Color fundus image
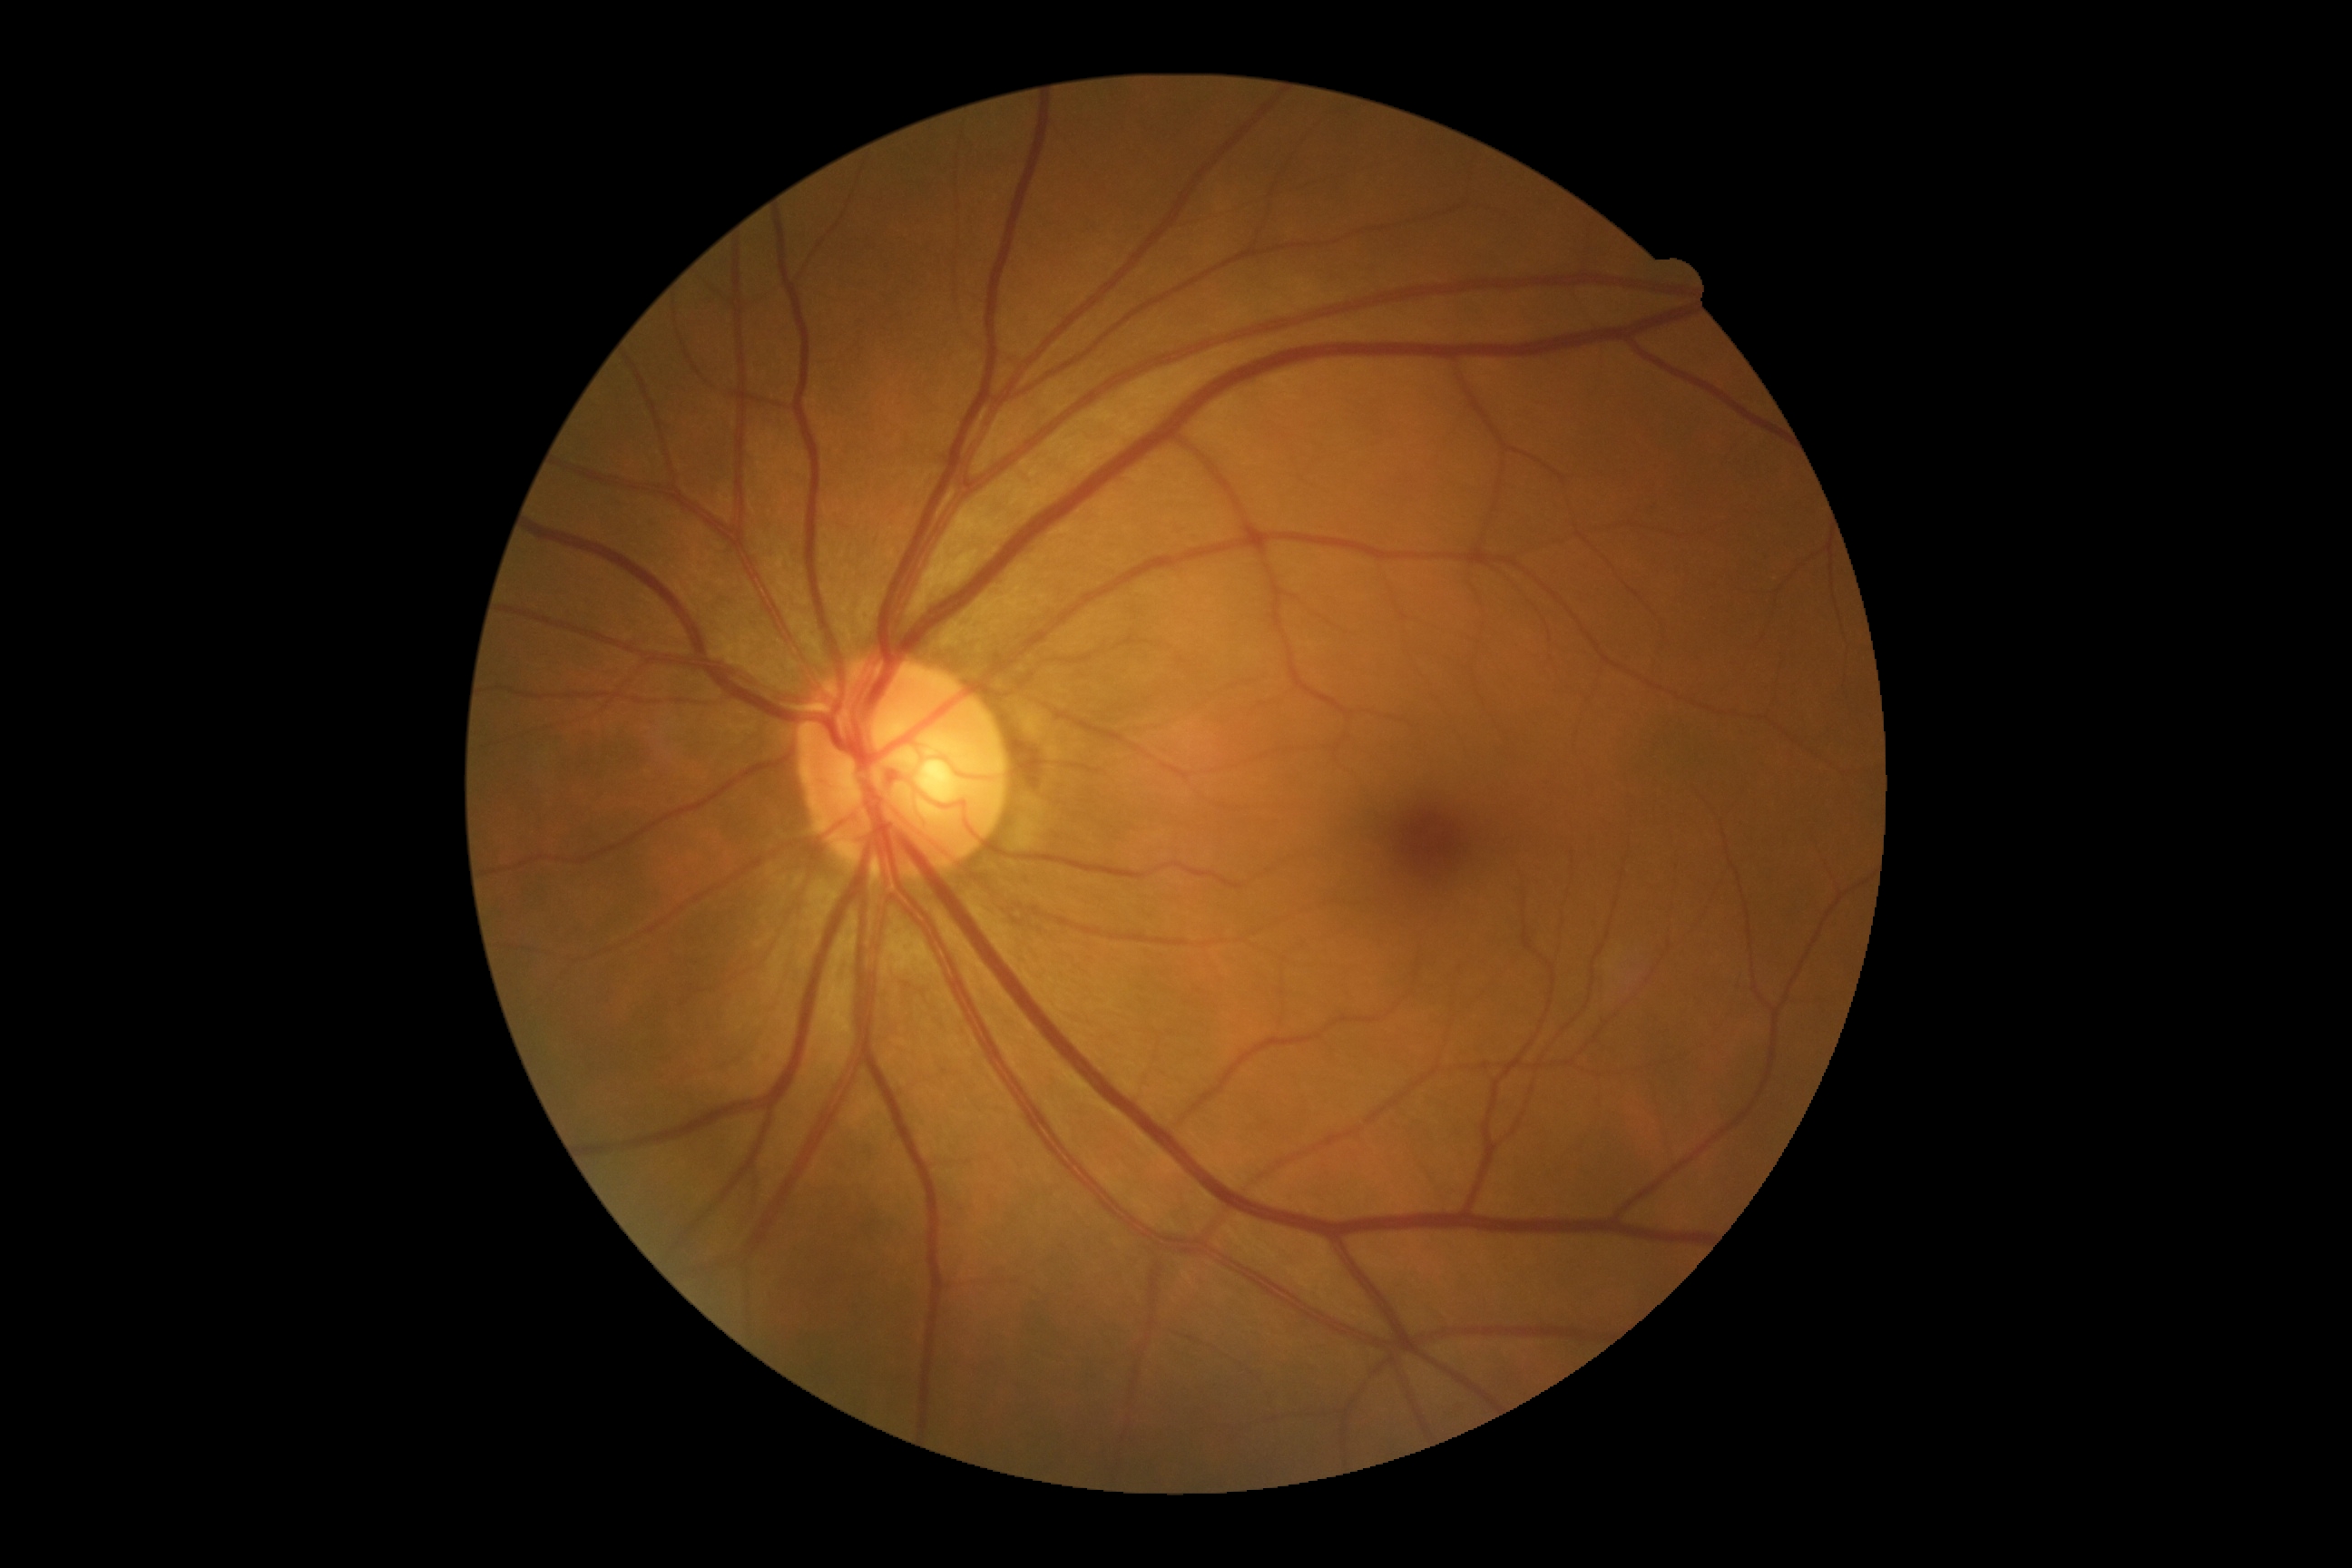

DR = 0/4
DR impression = negative for DR